Diabetic retinopathy graded by the modified Davis classification:
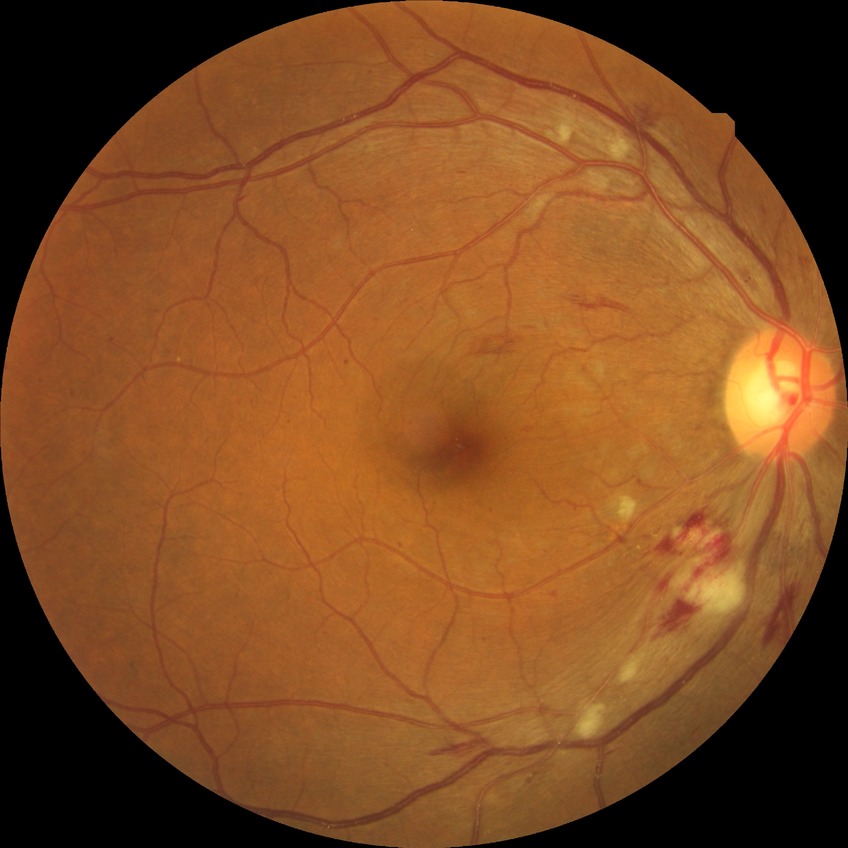

DR severity: PPDR.